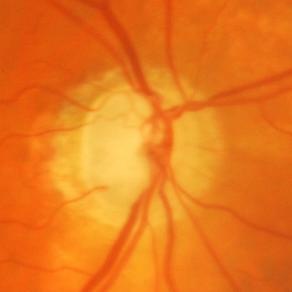

Glaucomatous changes.